2212x1661 · captured on a Topcon TRC-NW400 fundus camera — 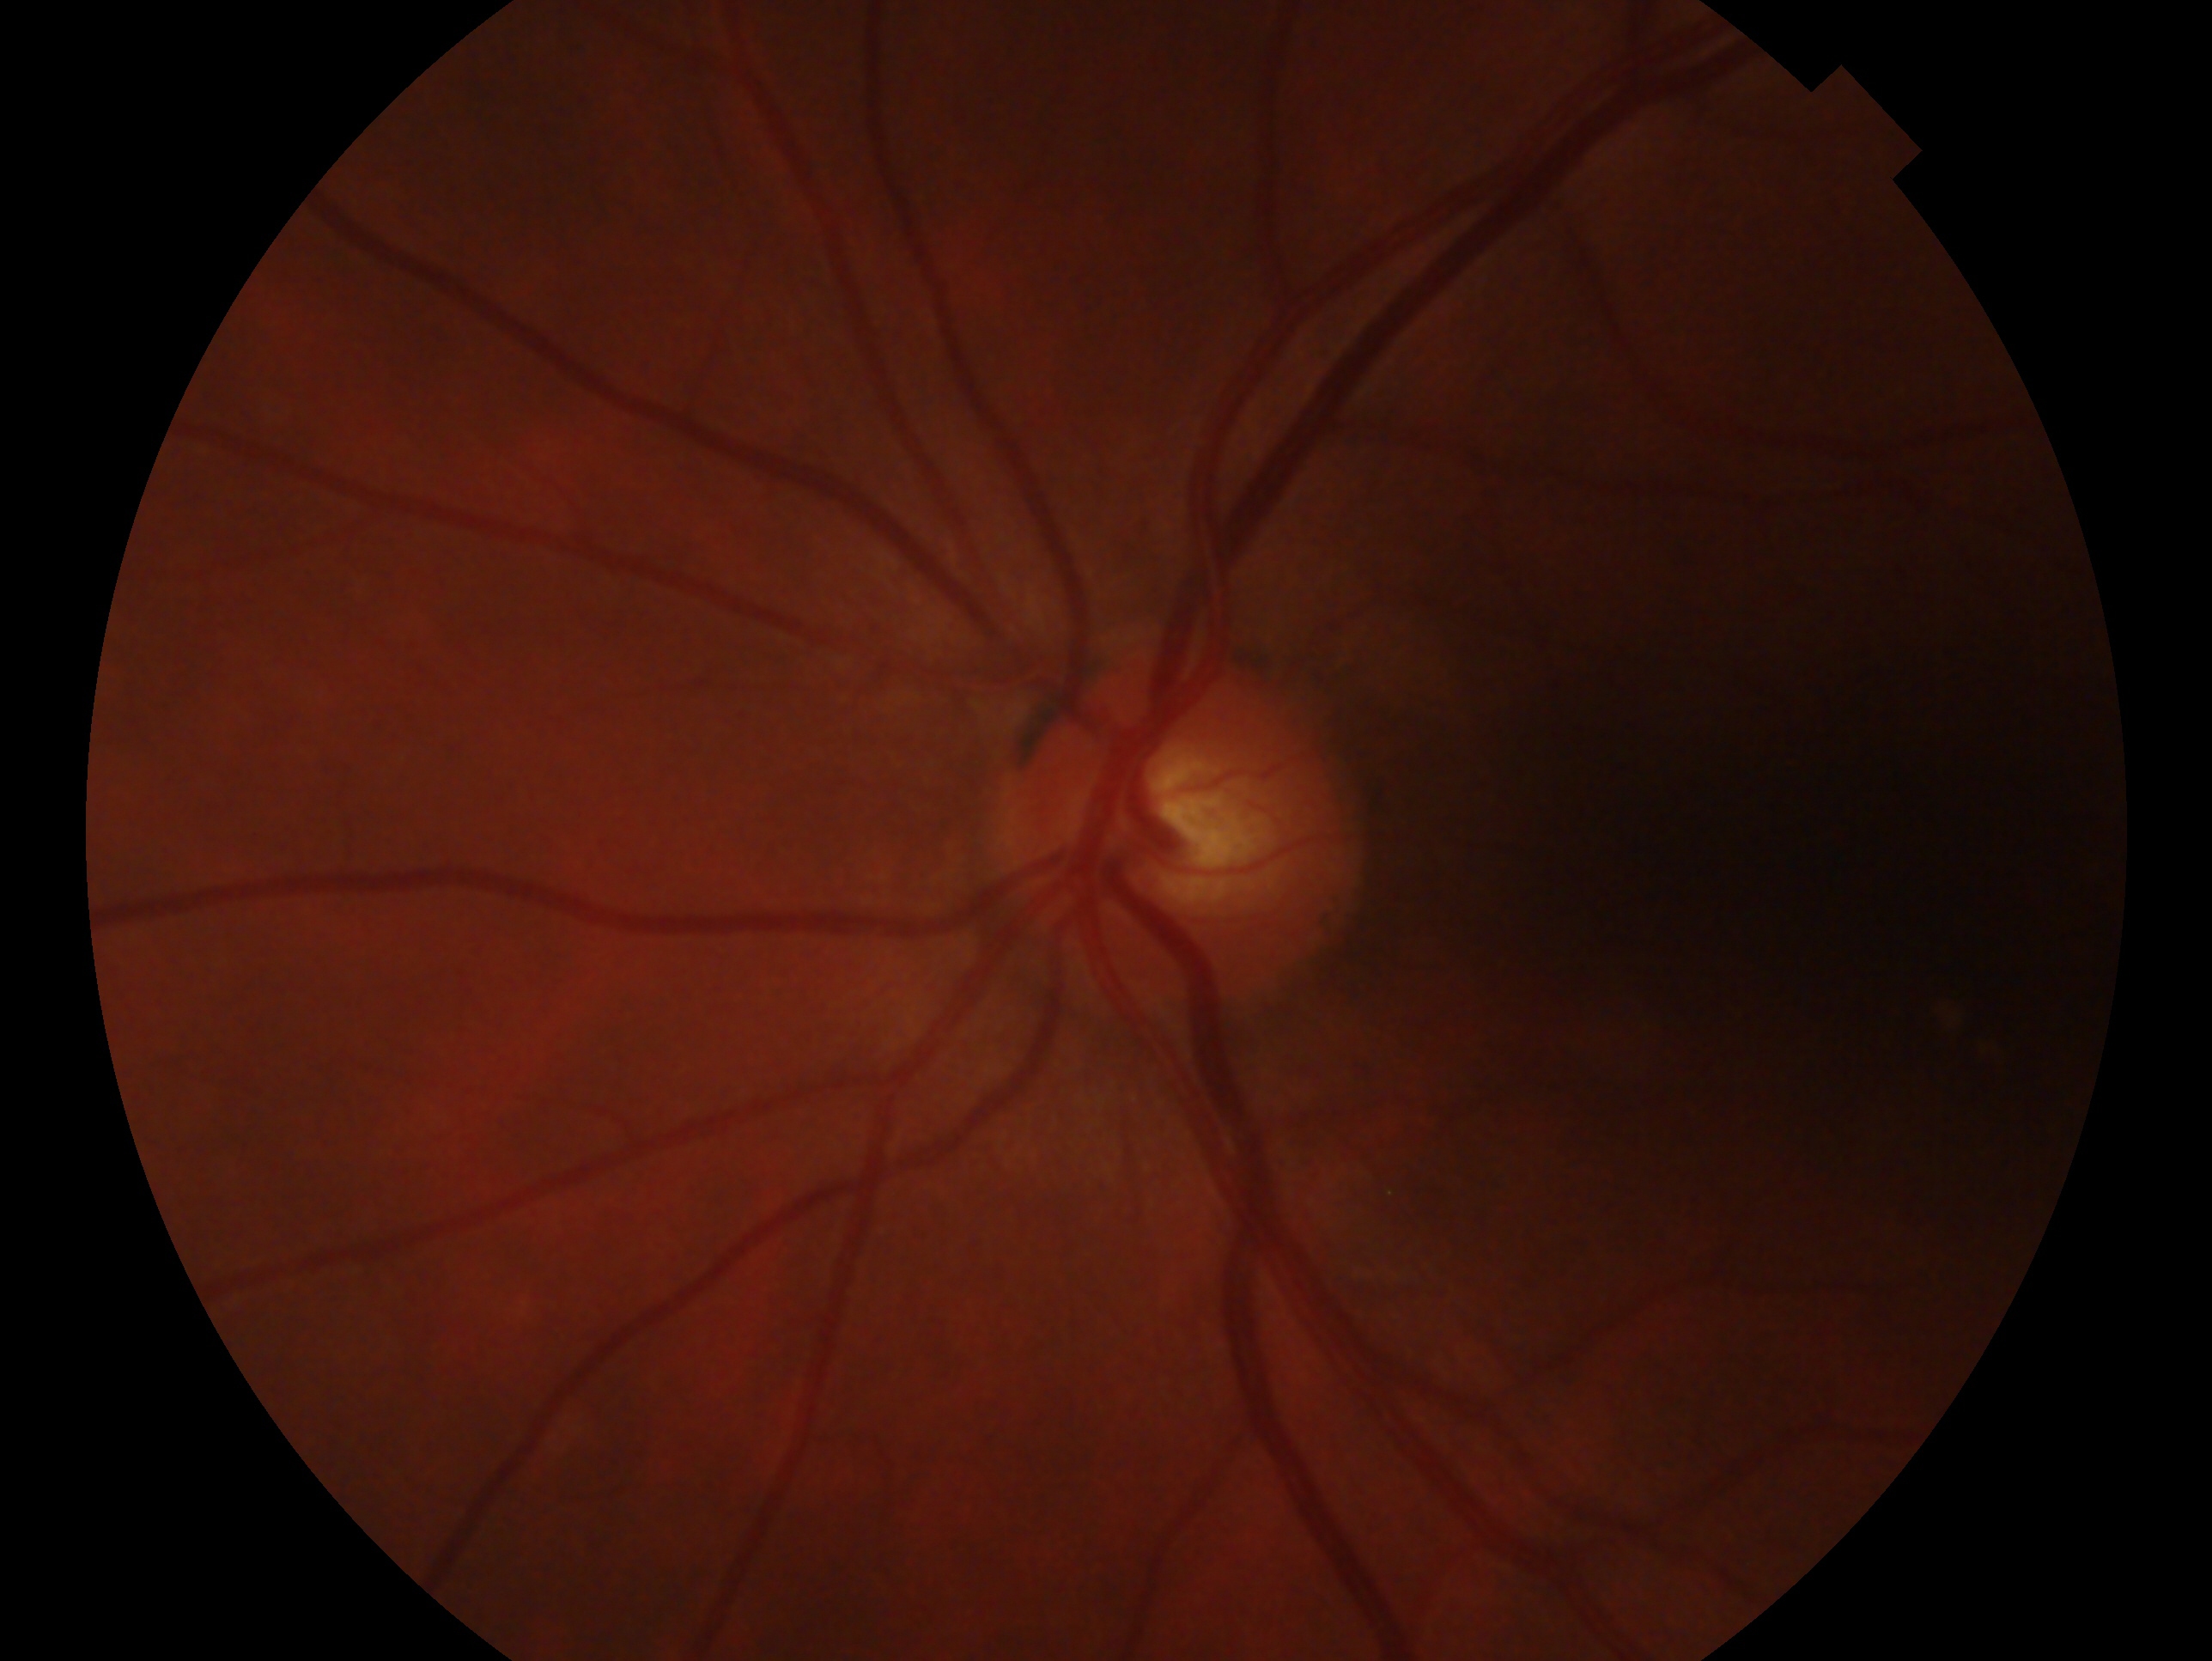 Annotations:
* laterality: left eye
* glaucoma status: negative for glaucoma